2352 x 1568 pixels.
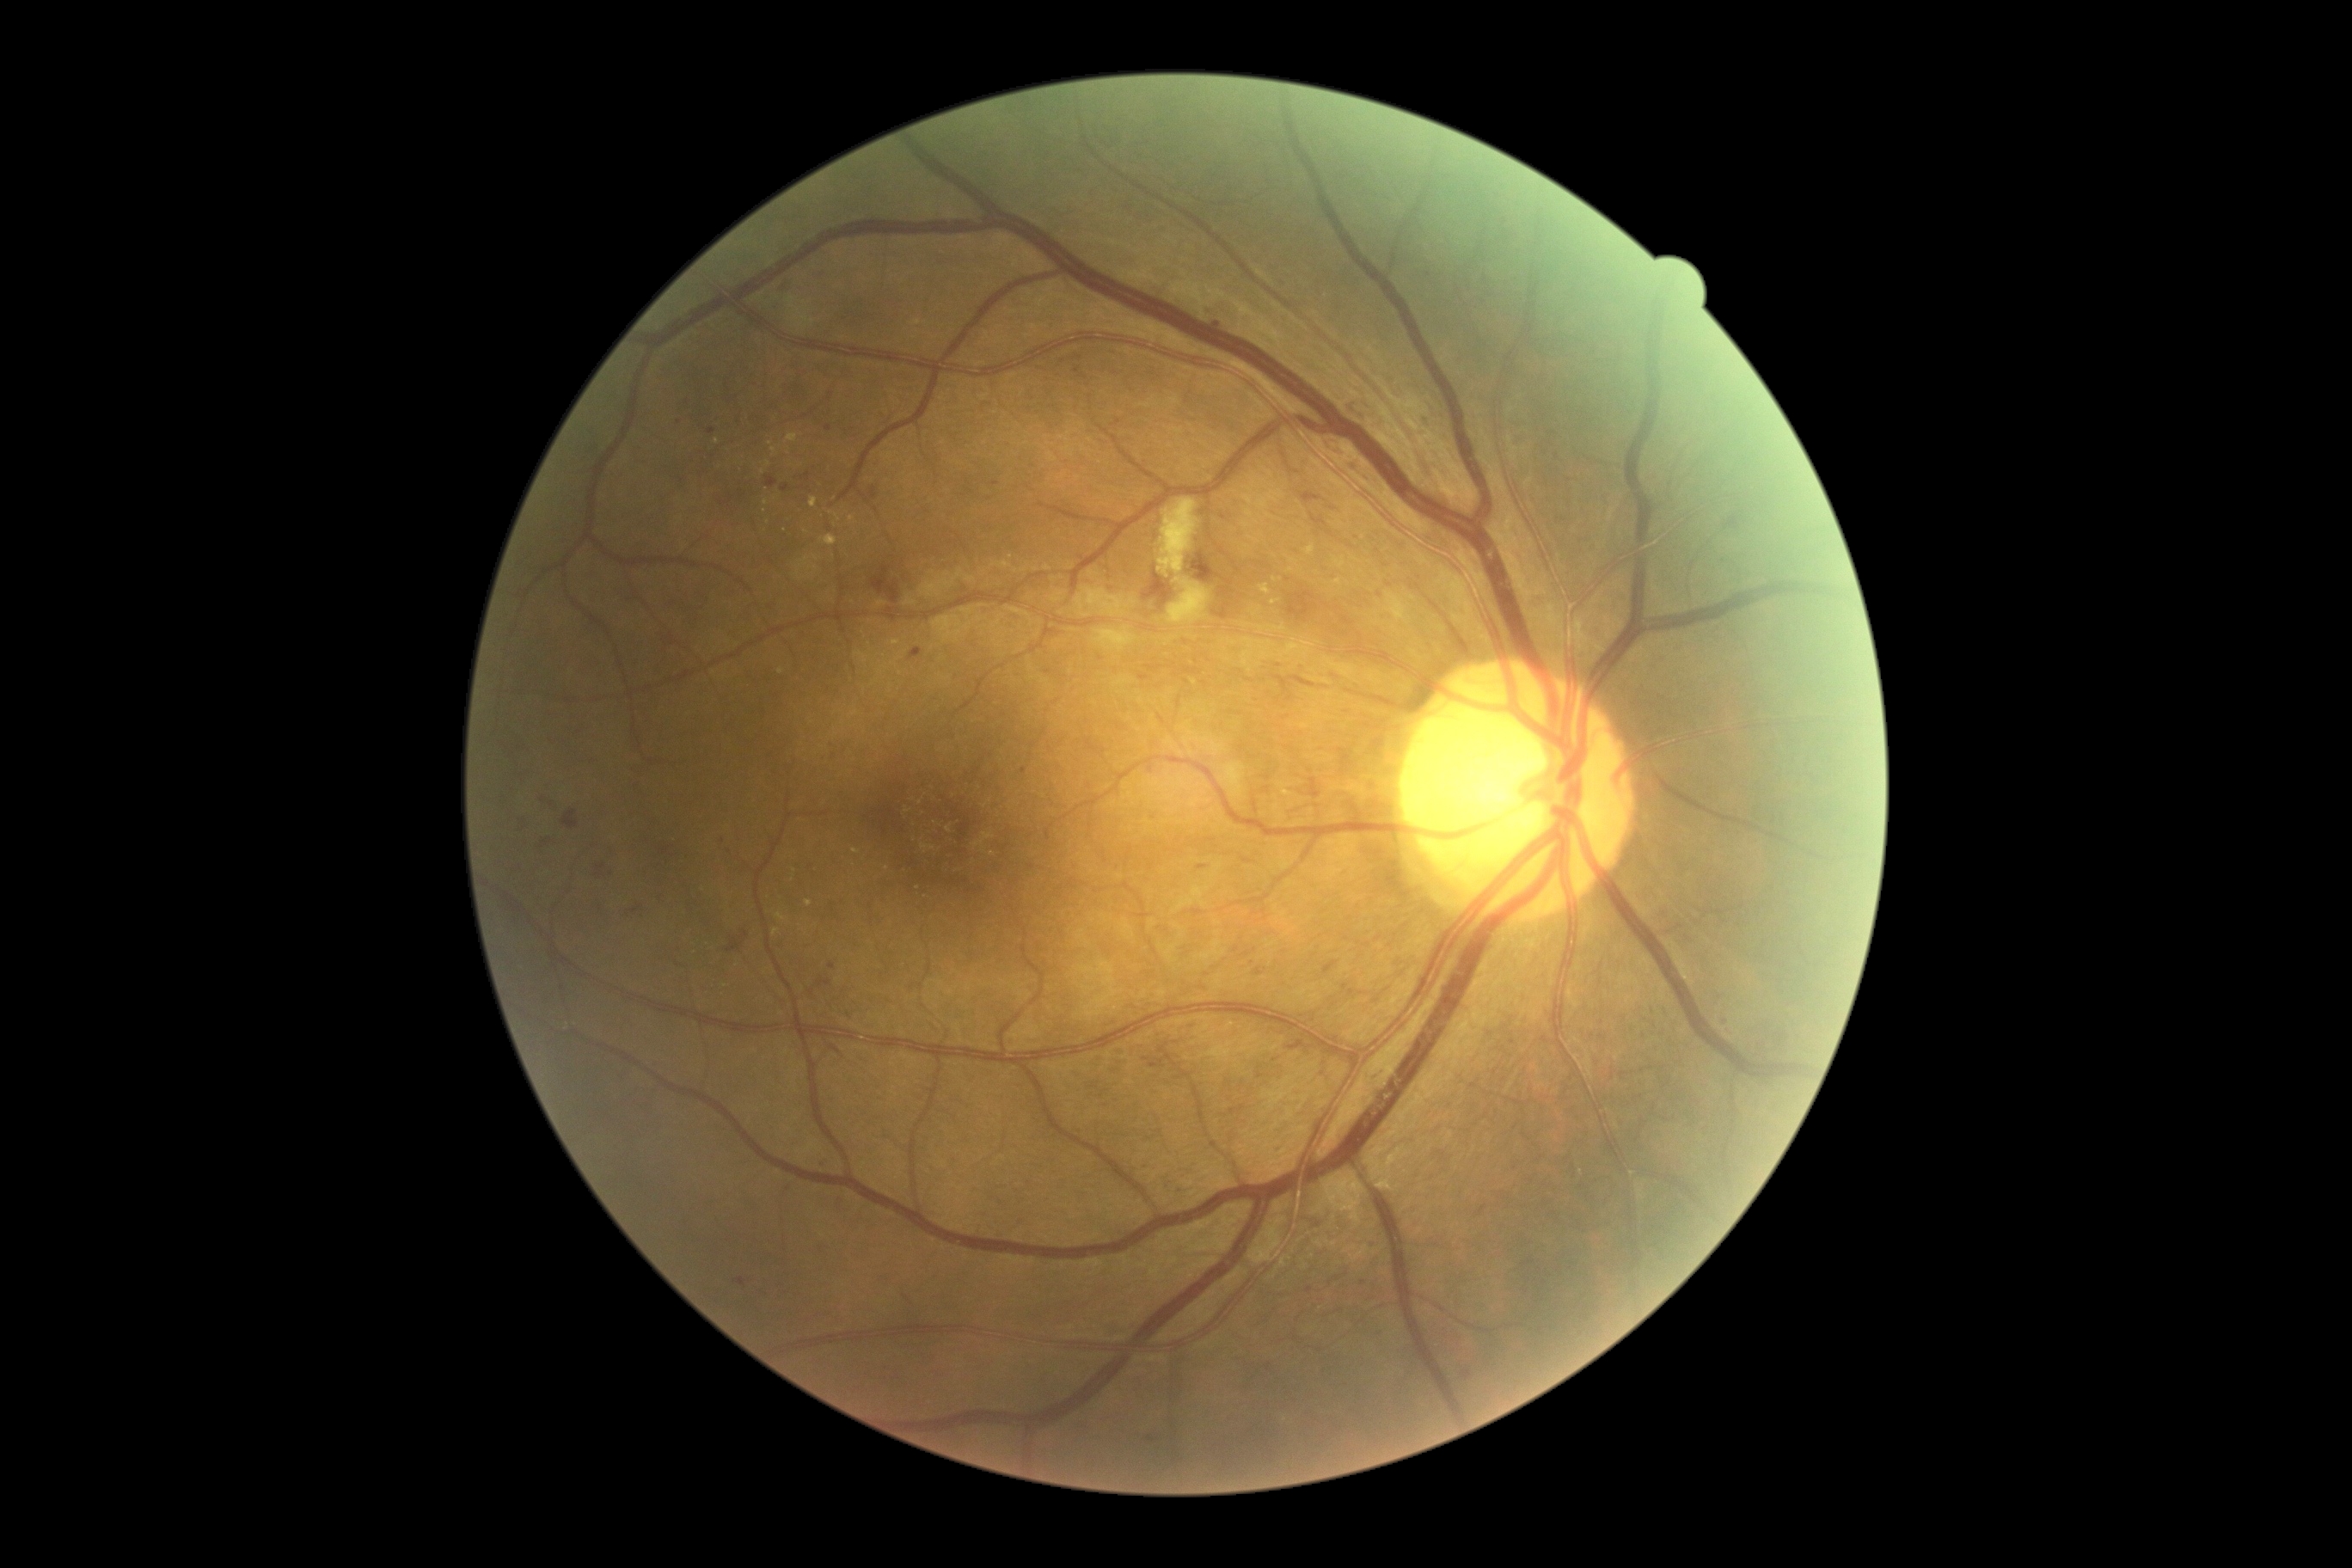
Diabetic retinopathy (DR) is 2
Representative lesions:
- soft exudates (SEs): [x1=1167, y1=577, x2=1211, y2=627]; [x1=787, y1=297, x2=814, y2=331]; [x1=1094, y1=628, x2=1137, y2=651]; [x1=1158, y1=498, x2=1201, y2=579]
- microaneurysms (MAs) (more not shown): [x1=675, y1=960, x2=682, y2=969]; [x1=1256, y1=967, x2=1263, y2=977]; [x1=737, y1=1278, x2=747, y2=1287]; [x1=1328, y1=444, x2=1344, y2=456]; [x1=816, y1=979, x2=831, y2=988]; [x1=781, y1=486, x2=790, y2=493]; [x1=1139, y1=675, x2=1151, y2=682]; [x1=805, y1=474, x2=811, y2=482]; [x1=1352, y1=462, x2=1359, y2=470]; [x1=1351, y1=401, x2=1364, y2=420]
- Small MAs approximately at <pt>1078,370</pt>; <pt>825,1163</pt>; <pt>1267,790</pt>; <pt>1380,595</pt>; <pt>1267,778</pt>; <pt>833,967</pt>; <pt>812,993</pt>
- hard exudates (EXs) (more not shown): [x1=1381, y1=1177, x2=1395, y2=1191]; [x1=1387, y1=592, x2=1407, y2=622]; [x1=974, y1=833, x2=995, y2=848]; [x1=805, y1=900, x2=814, y2=909]; [x1=1271, y1=599, x2=1280, y2=606]; [x1=812, y1=554, x2=821, y2=561]; [x1=1259, y1=585, x2=1271, y2=596]; [x1=921, y1=845, x2=936, y2=854]; [x1=776, y1=914, x2=787, y2=922]
- Small EXs approximately at <pt>1285,1420</pt>; <pt>920,803</pt>; <pt>993,854</pt>; <pt>781,672</pt>; <pt>776,932</pt>; <pt>949,829</pt>; <pt>1413,598</pt>; <pt>919,888</pt>; <pt>795,871</pt>; <pt>852,519</pt>; <pt>766,503</pt>
- hemorrhages (HEs): [x1=1189, y1=551, x2=1222, y2=584]; [x1=1727, y1=518, x2=1739, y2=529]; [x1=871, y1=567, x2=900, y2=604]; [x1=1213, y1=604, x2=1230, y2=622]; [x1=764, y1=475, x2=778, y2=489]; [x1=563, y1=811, x2=579, y2=830]; [x1=1220, y1=587, x2=1230, y2=597]; [x1=596, y1=864, x2=606, y2=874]; [x1=1144, y1=572, x2=1173, y2=609]; [x1=1287, y1=591, x2=1314, y2=622]; [x1=726, y1=938, x2=744, y2=953]